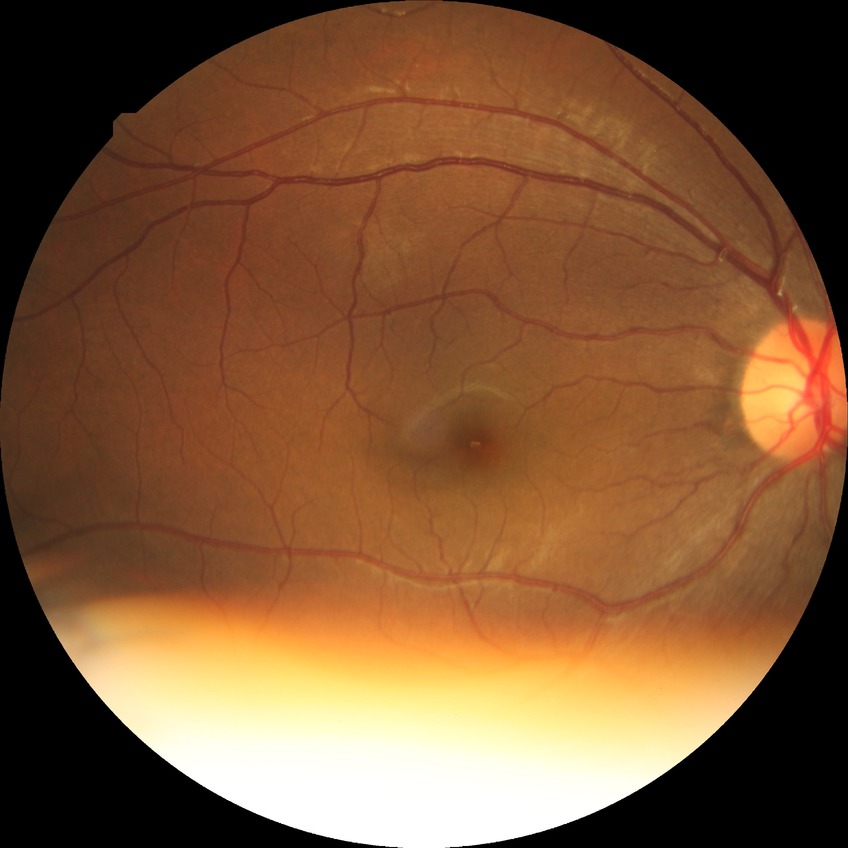

Diabetic retinopathy (DR): no diabetic retinopathy (NDR).